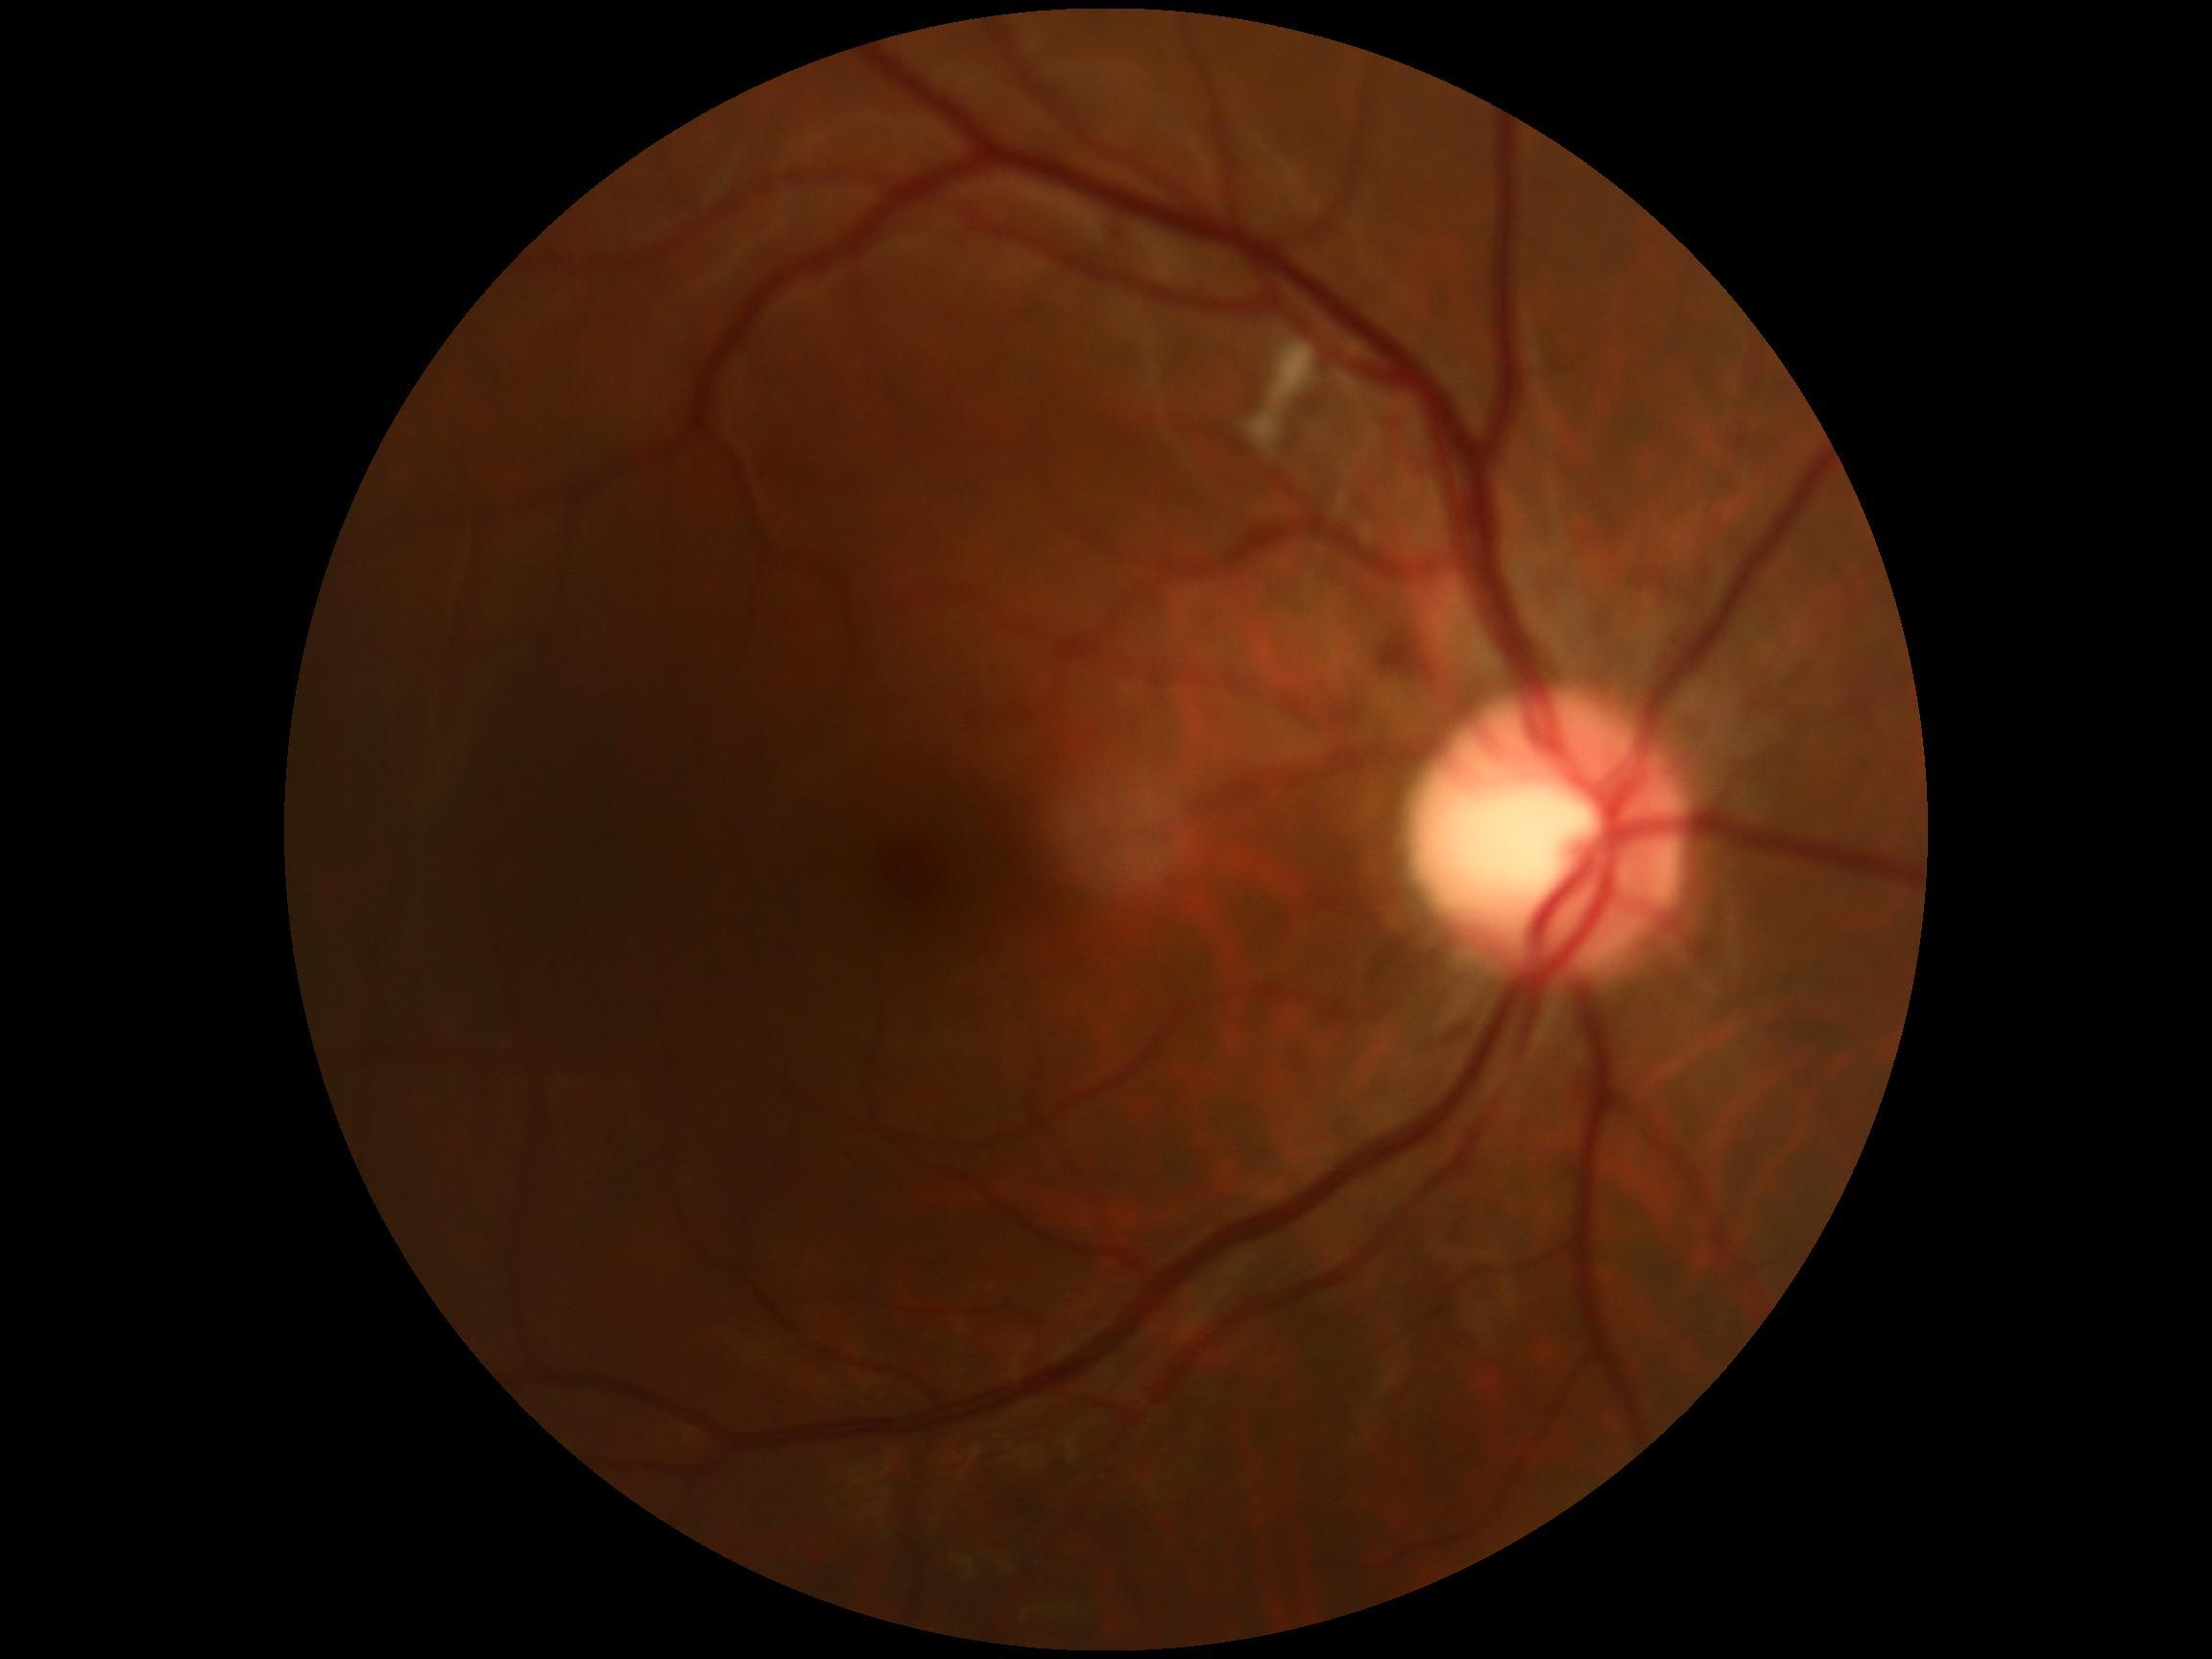

DR grade: 2 (moderate NPDR).